2089 by 1764 pixels — 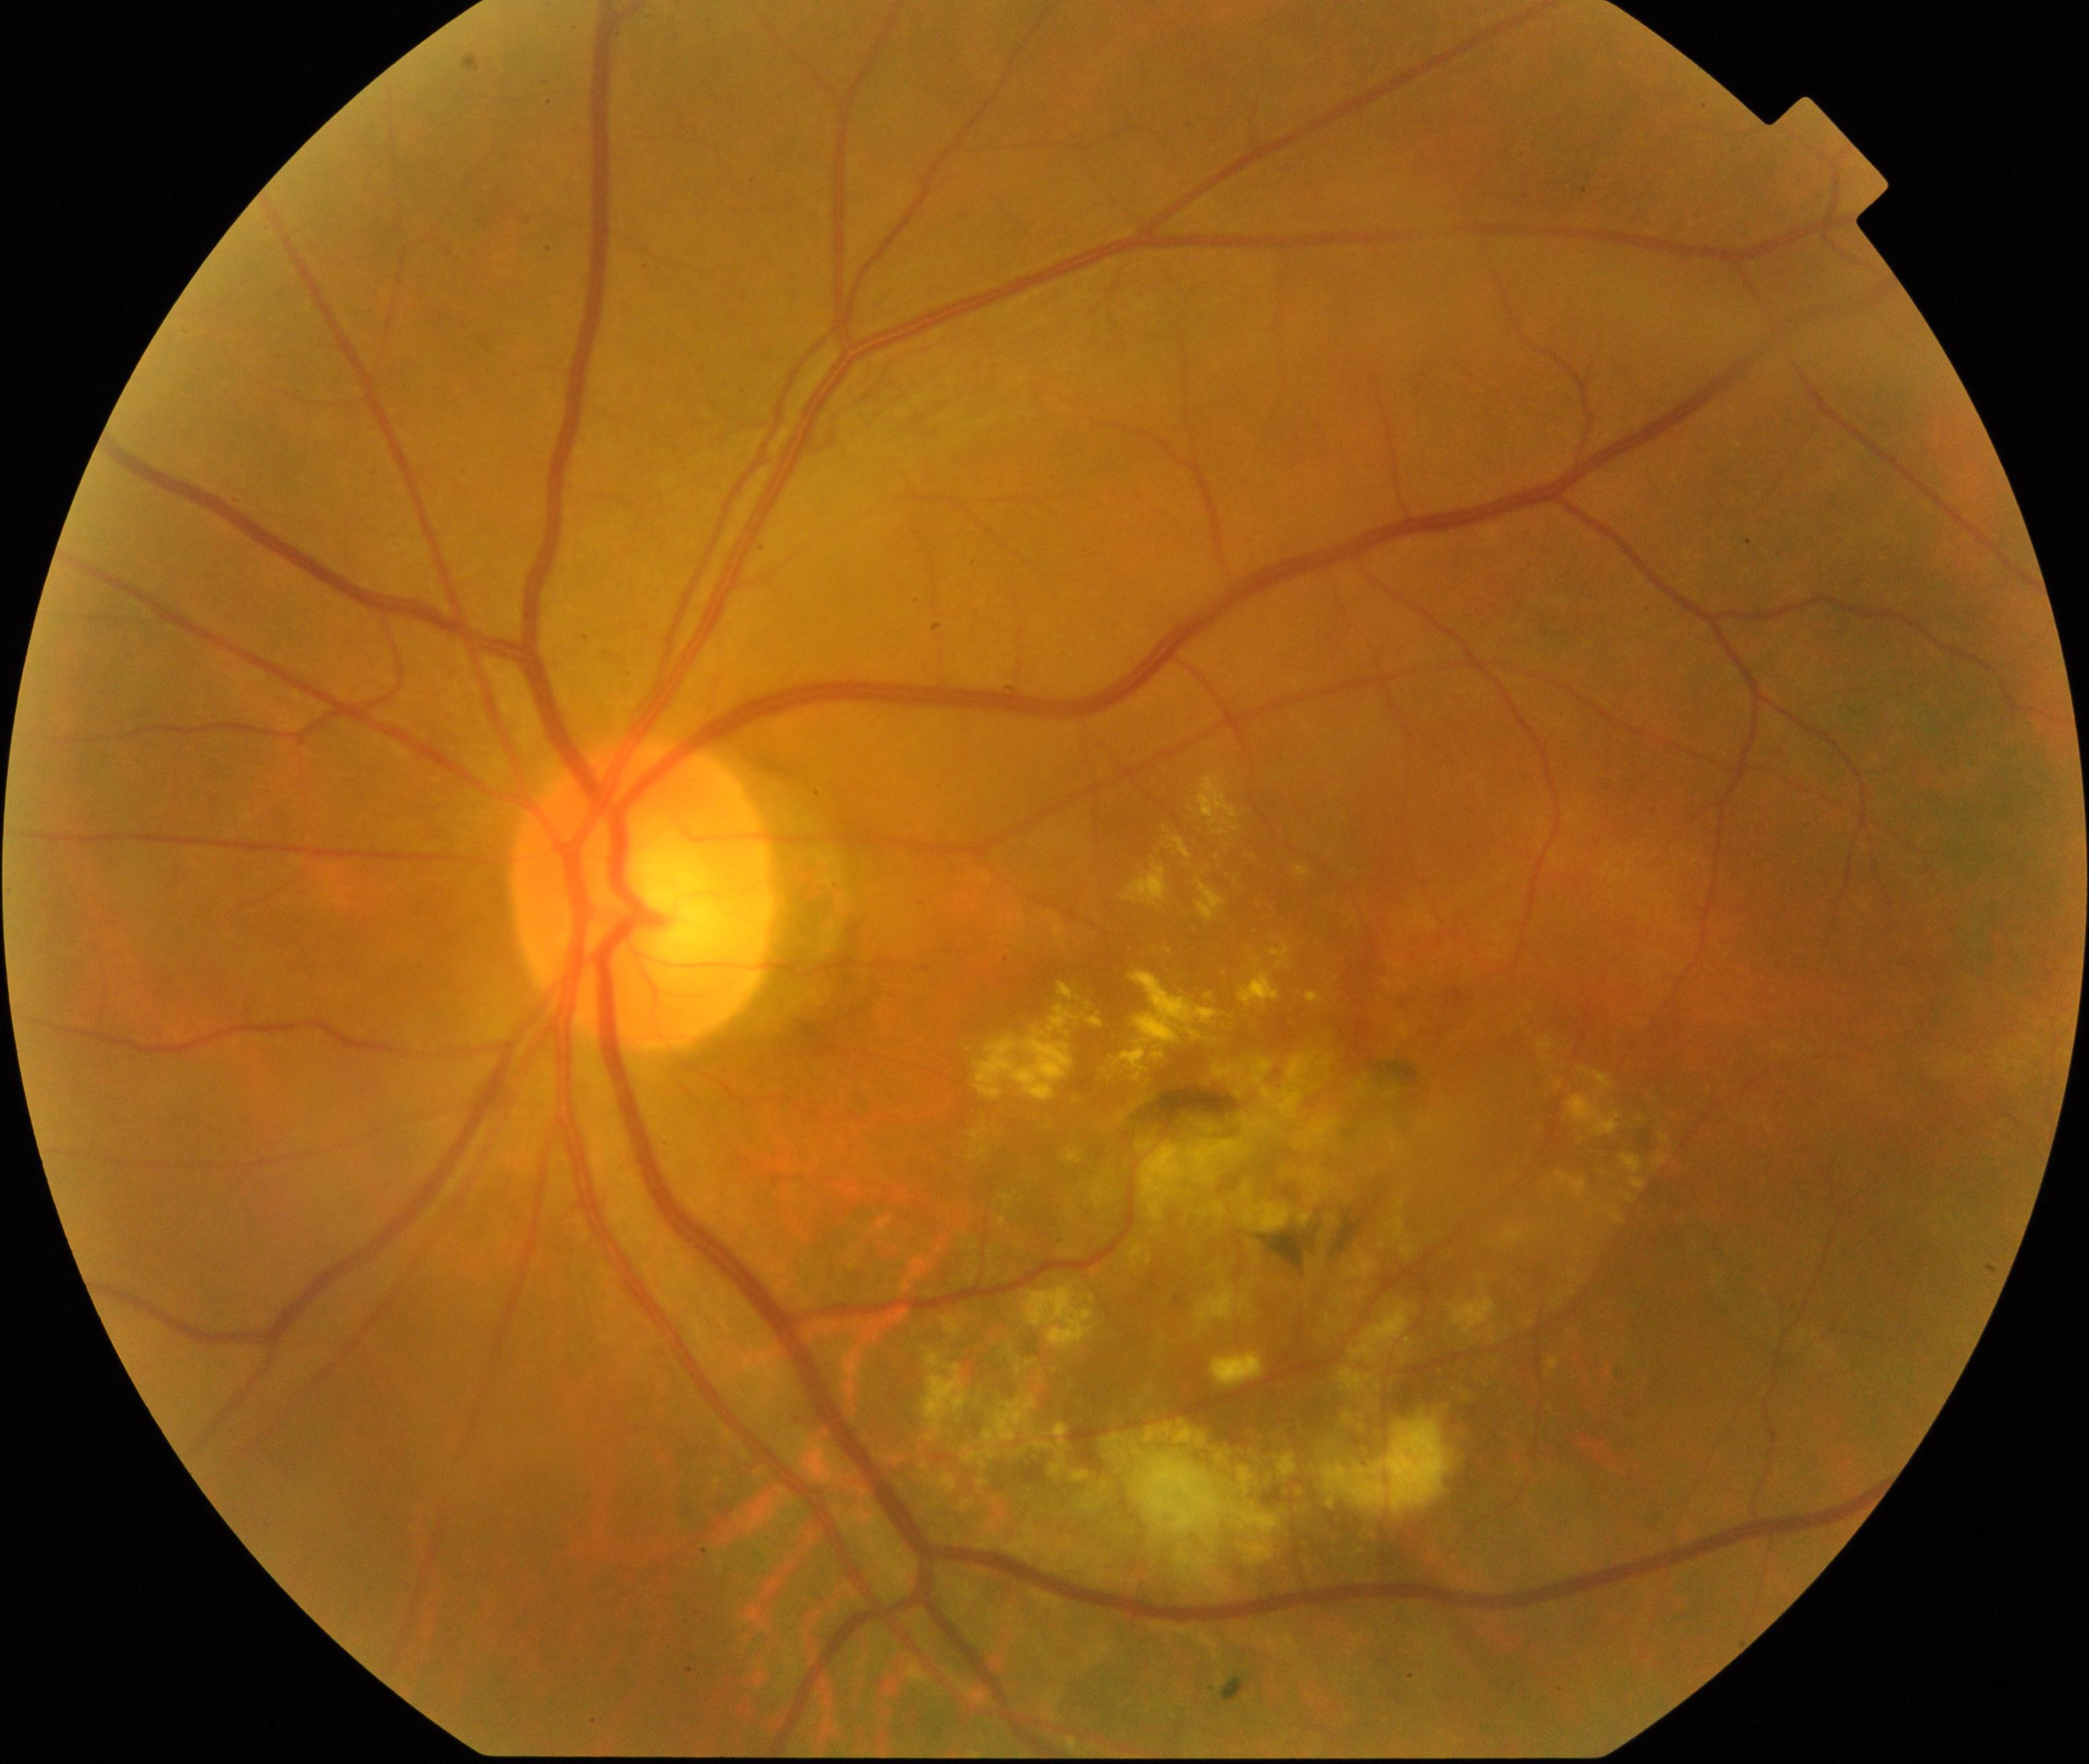

Fundus image consistent with maculopathy.